Nonmydriatic, color fundus photograph, 45-degree field of view, DR severity per modified Davis staging:
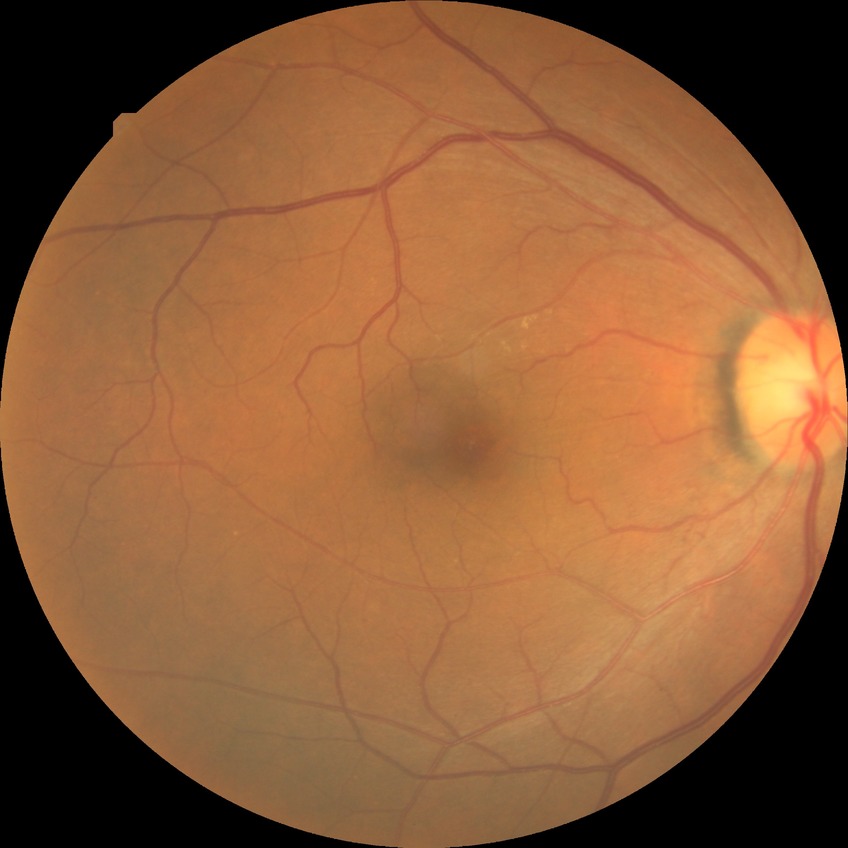
Diabetic retinopathy (DR) is NDR (no diabetic retinopathy).